Infant wide-field fundus photograph · 130° field of view (Clarity RetCam 3) — 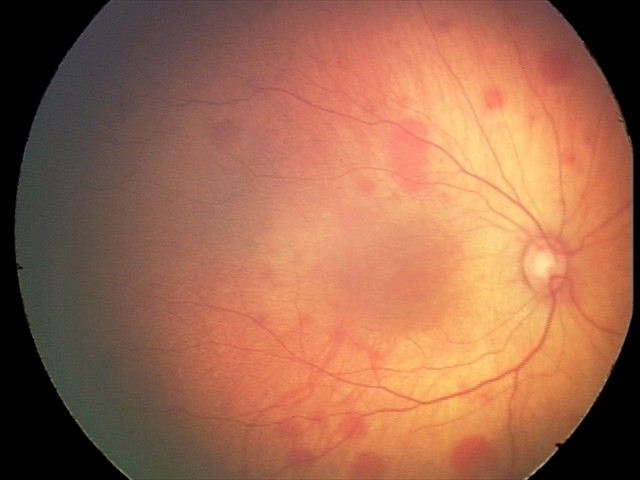 Impression: retinal hemorrhages.